2352x1568 · color fundus image · 45° FOV — 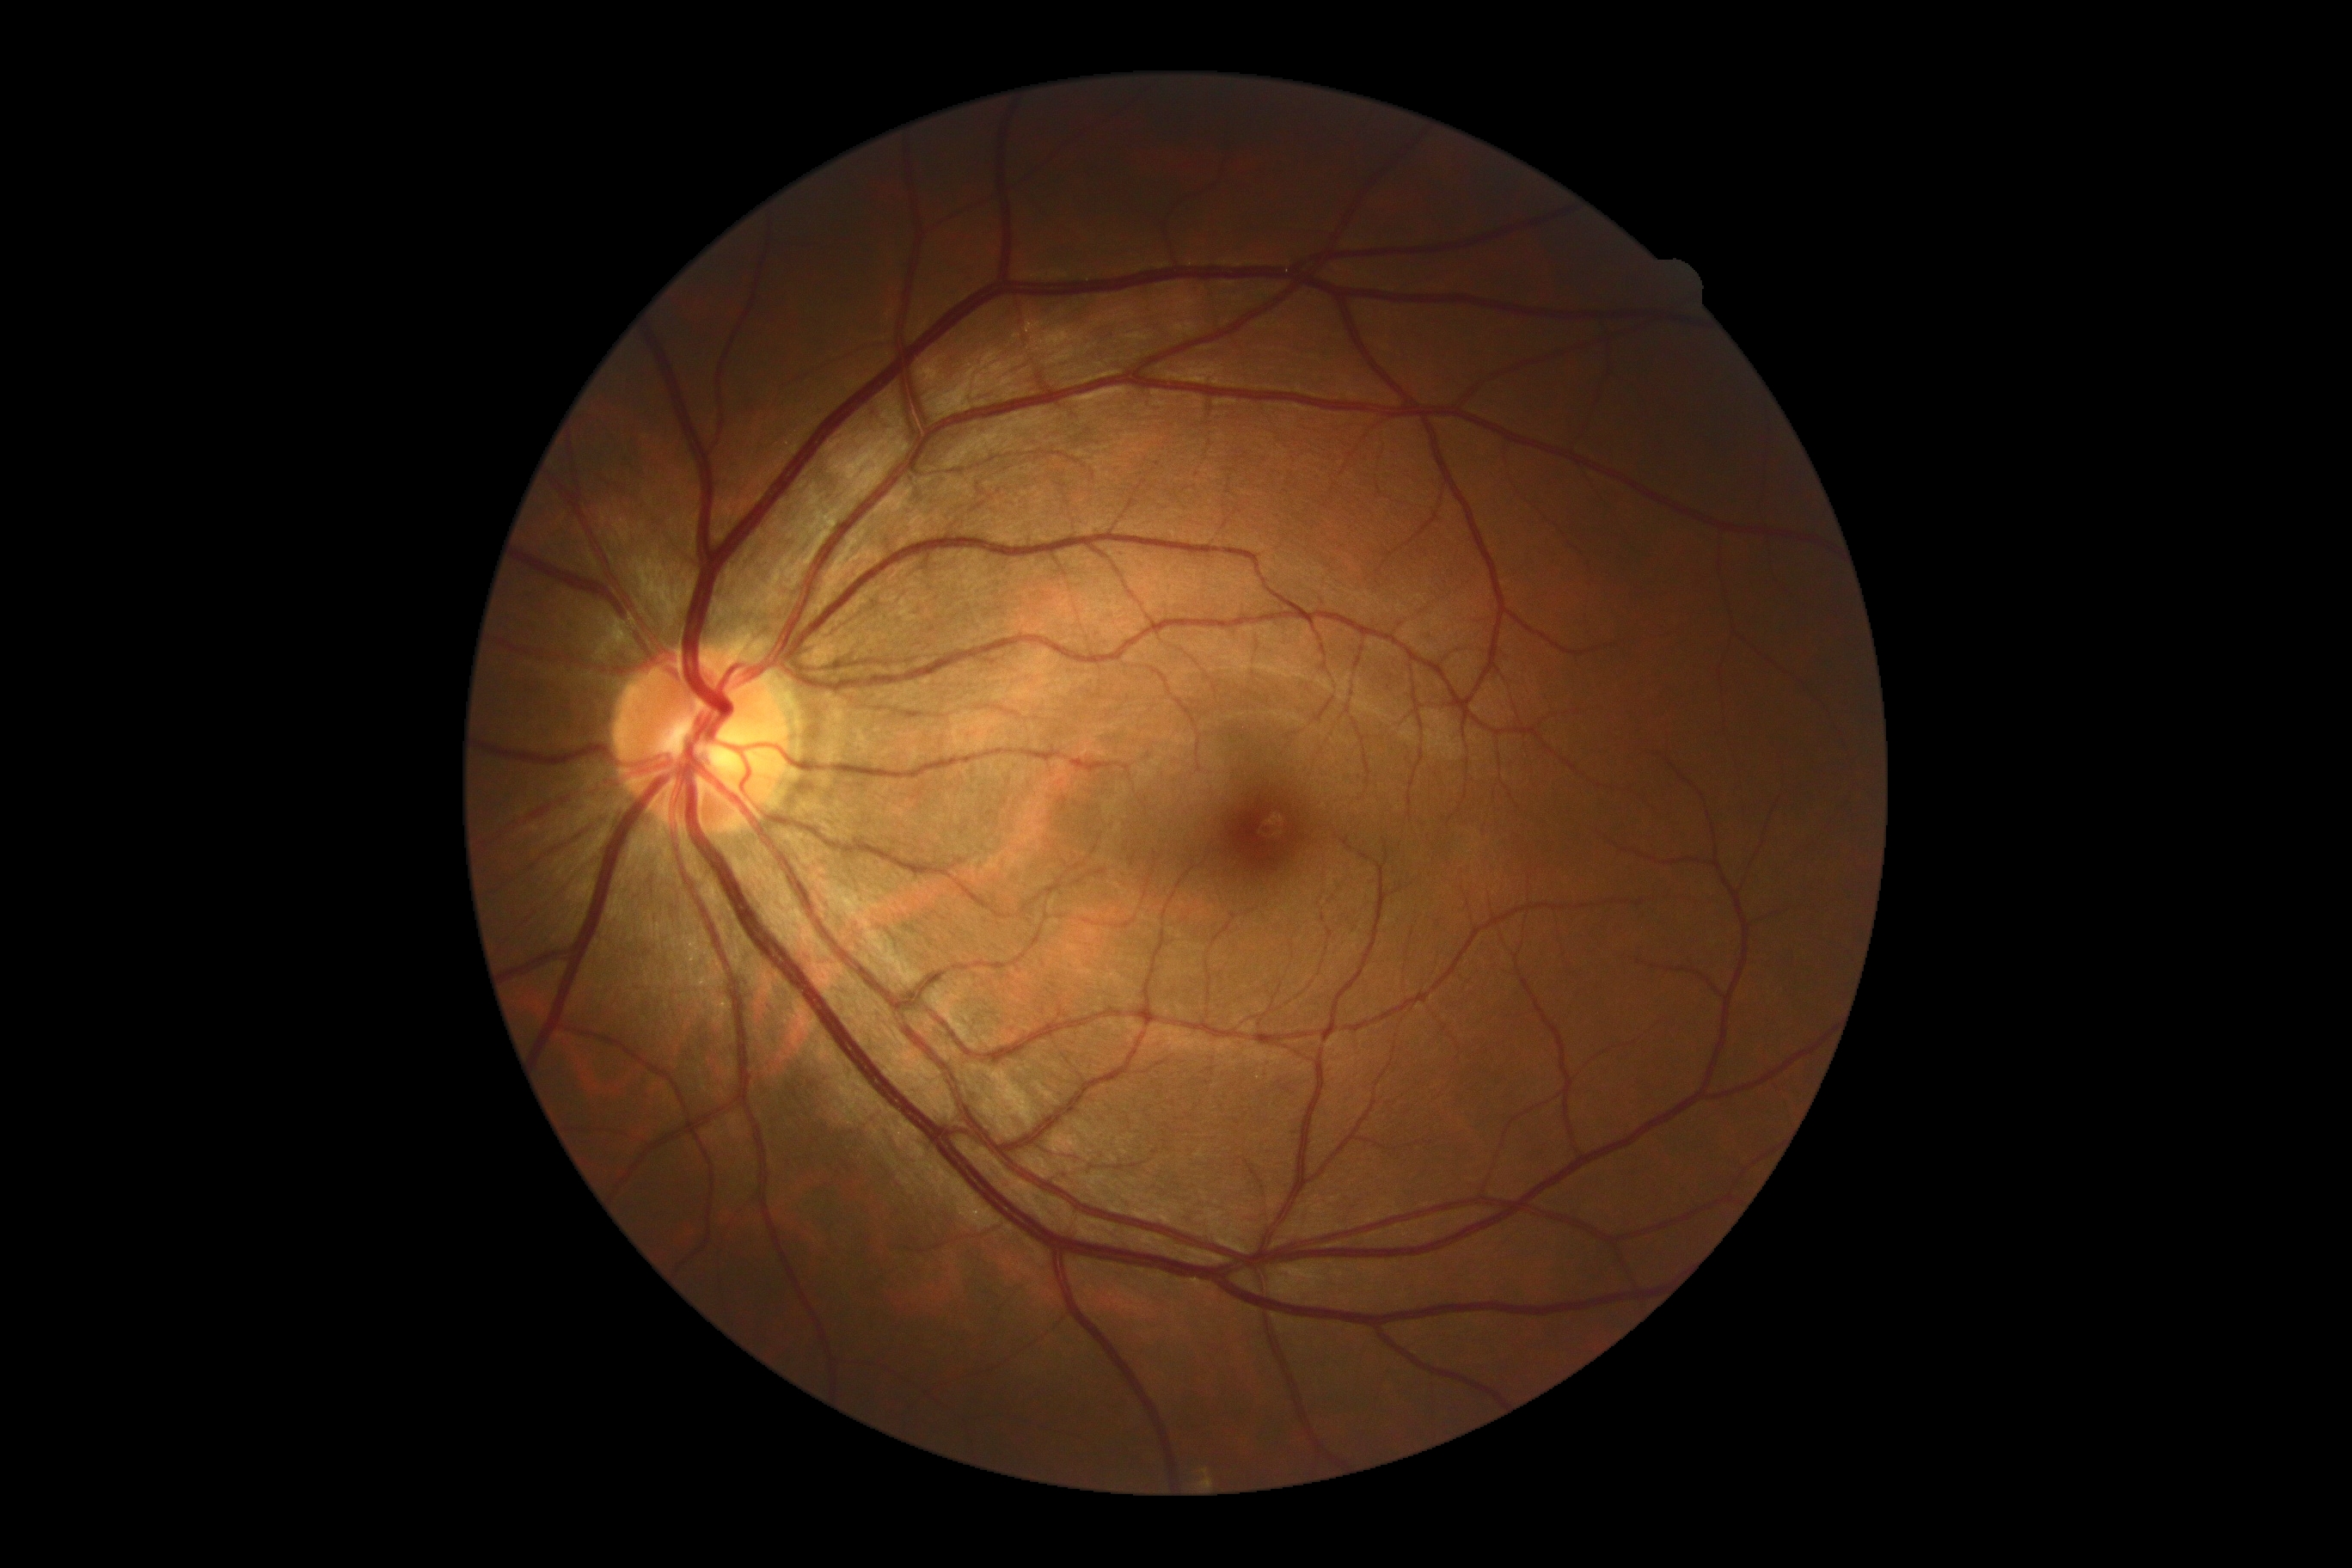

No diabetic retinal disease findings.
Retinopathy is grade 0.